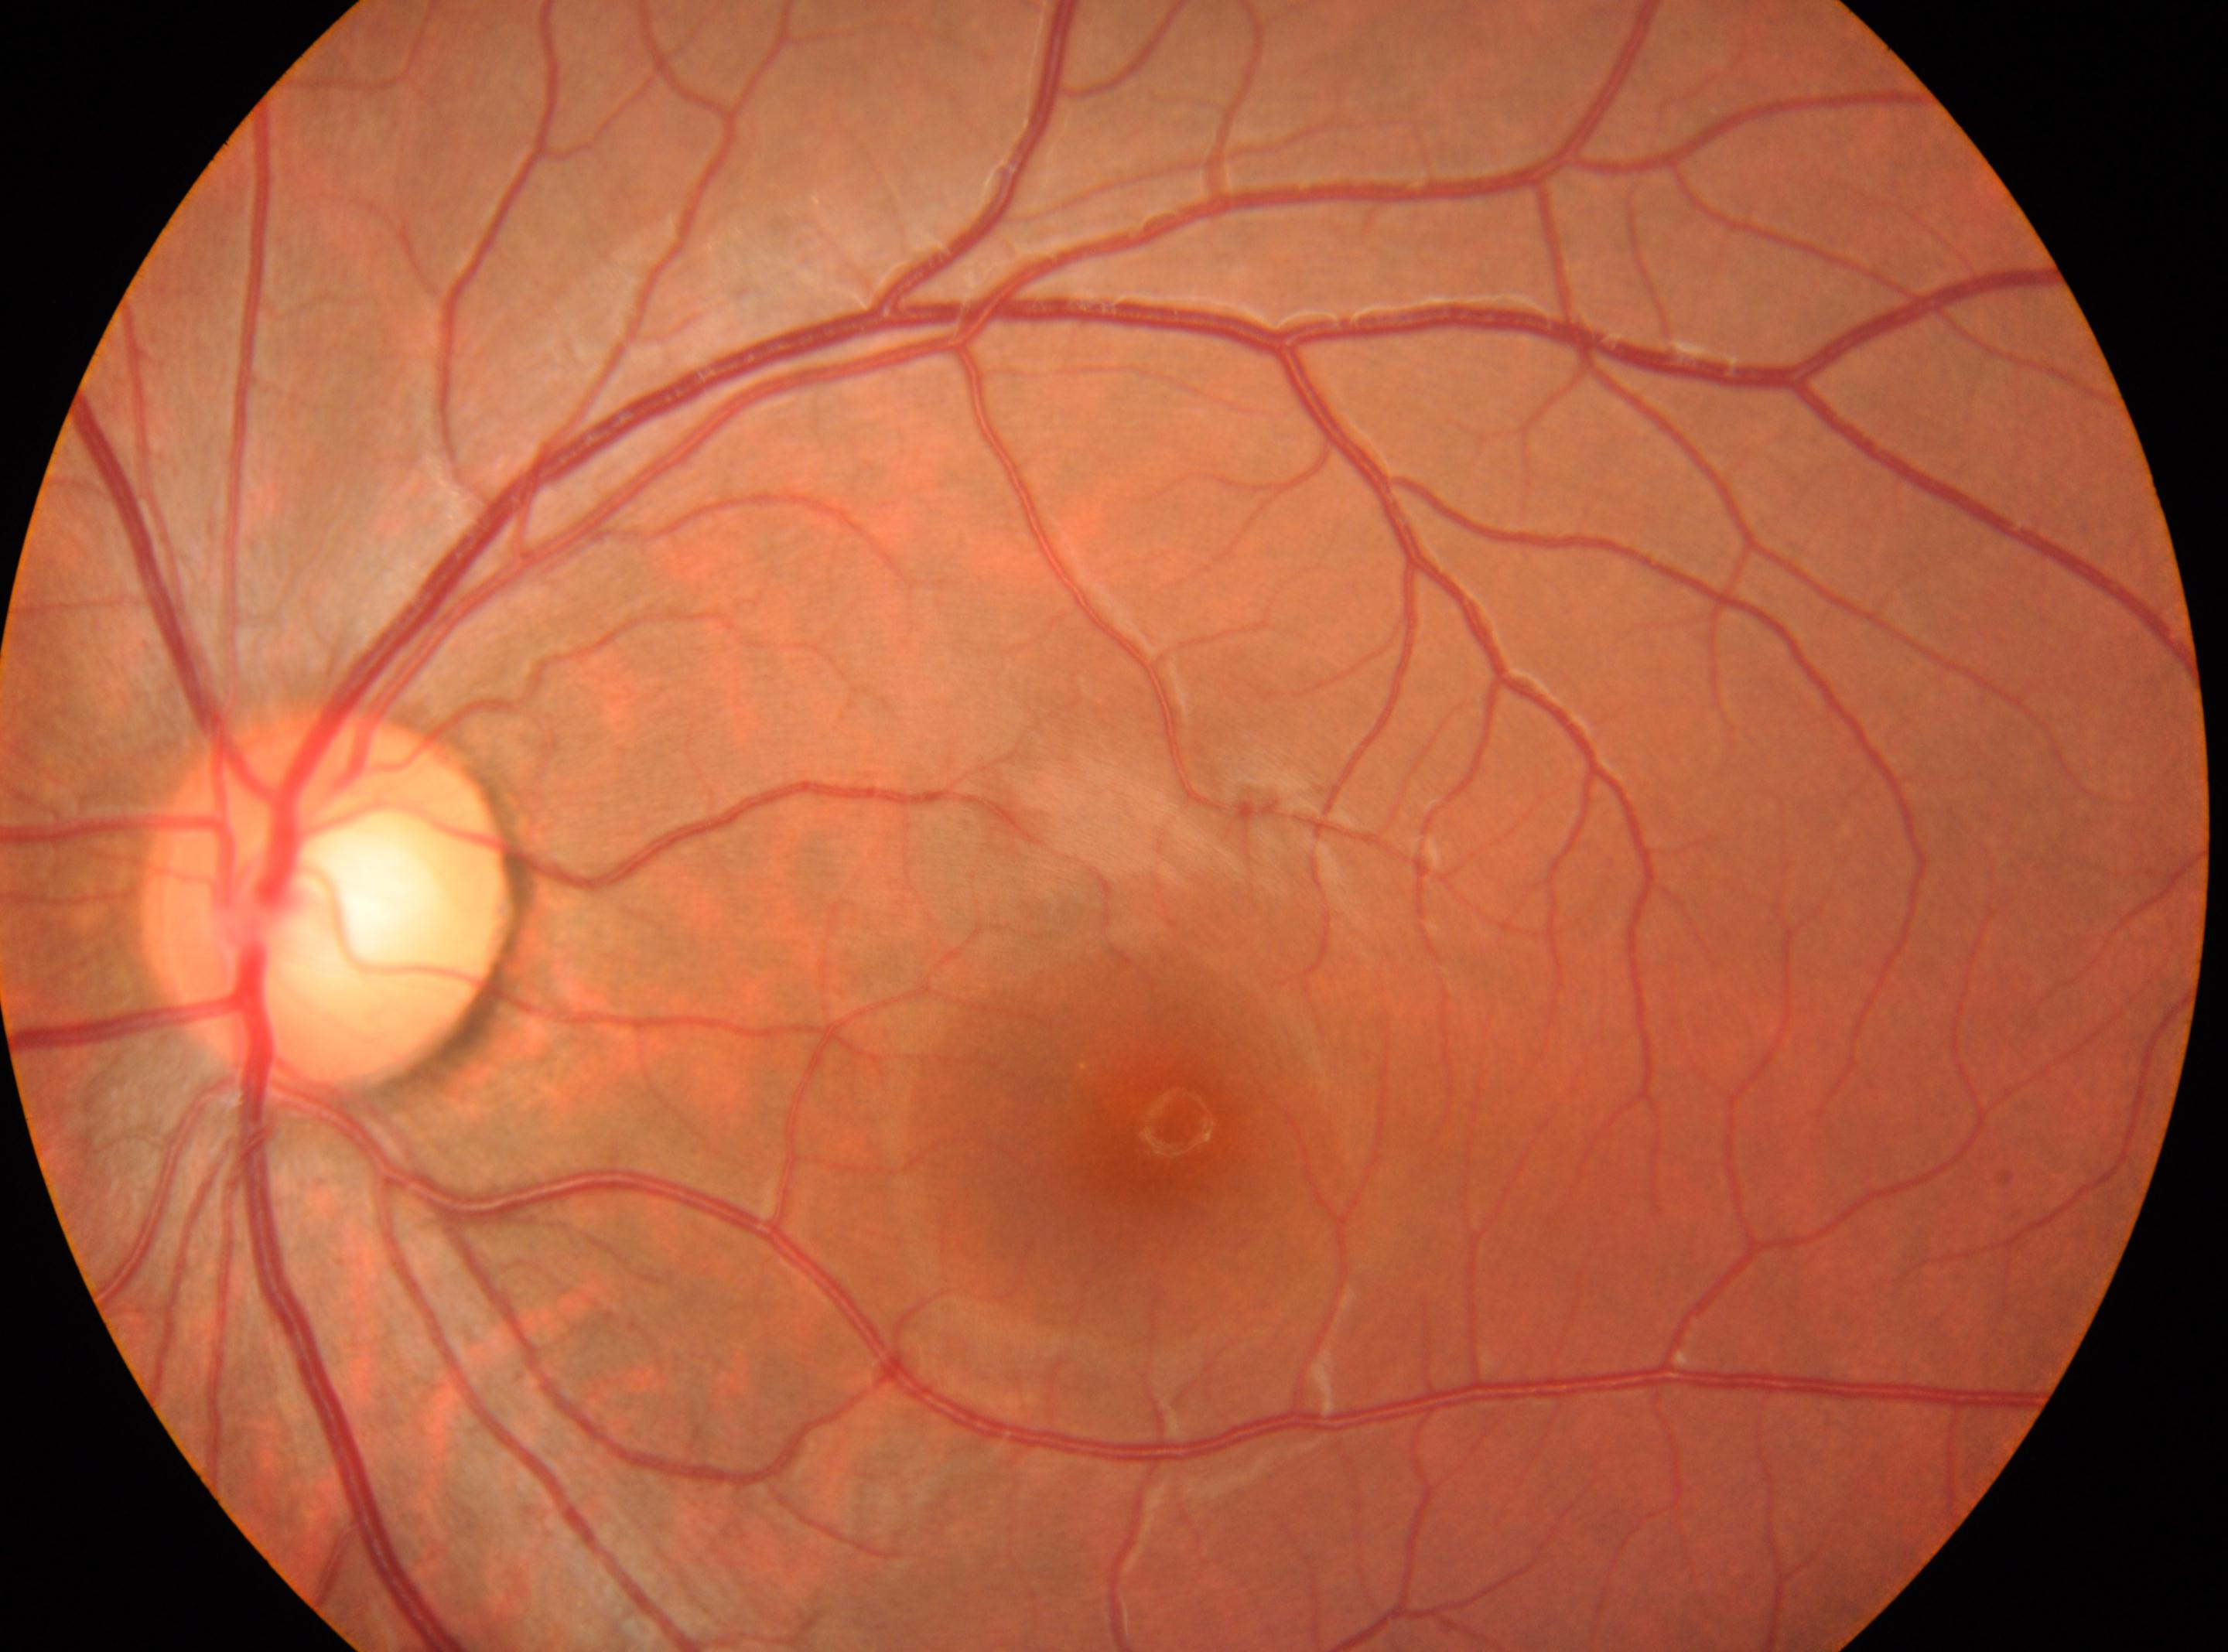
| feature | annotation |
|---|---|
| ONH | (333, 905) |
| fovea | (1159, 1126) |
| diabetic retinopathy severity | 0 |
| eye | OS |